Infant wide-field fundus photograph
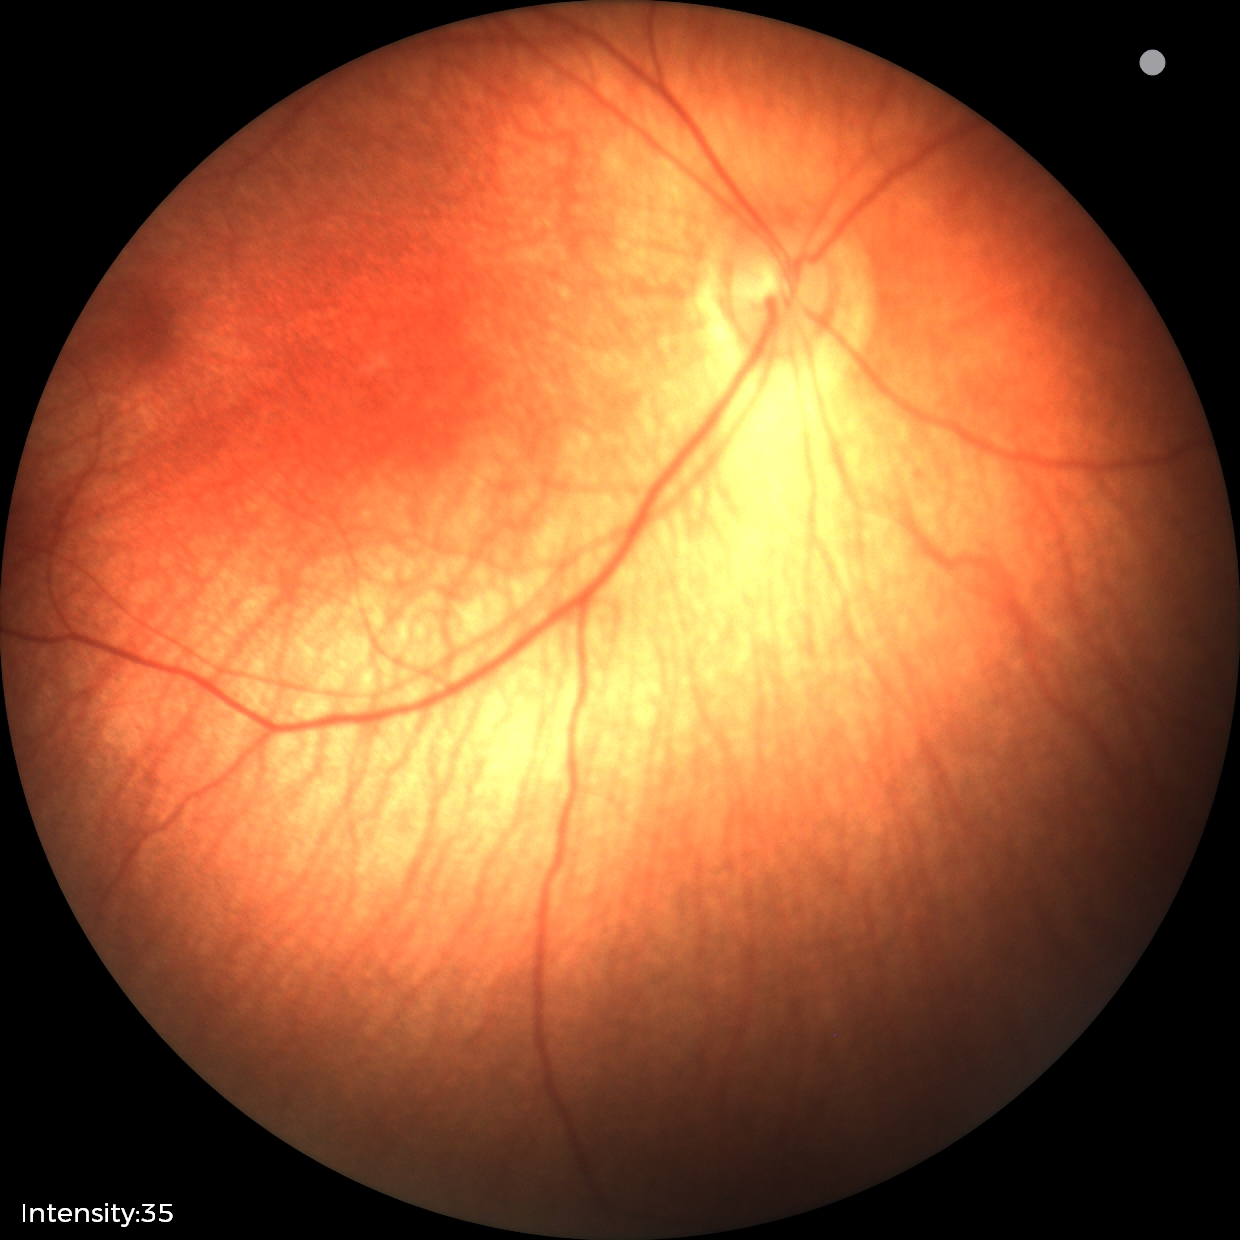

Q: What is the diagnosis from this examination?
A: normal fundus examination